Phoenix ICON wide-field infant fundus image. Captured with the Phoenix ICON (100° field of view). 1240x1240px.
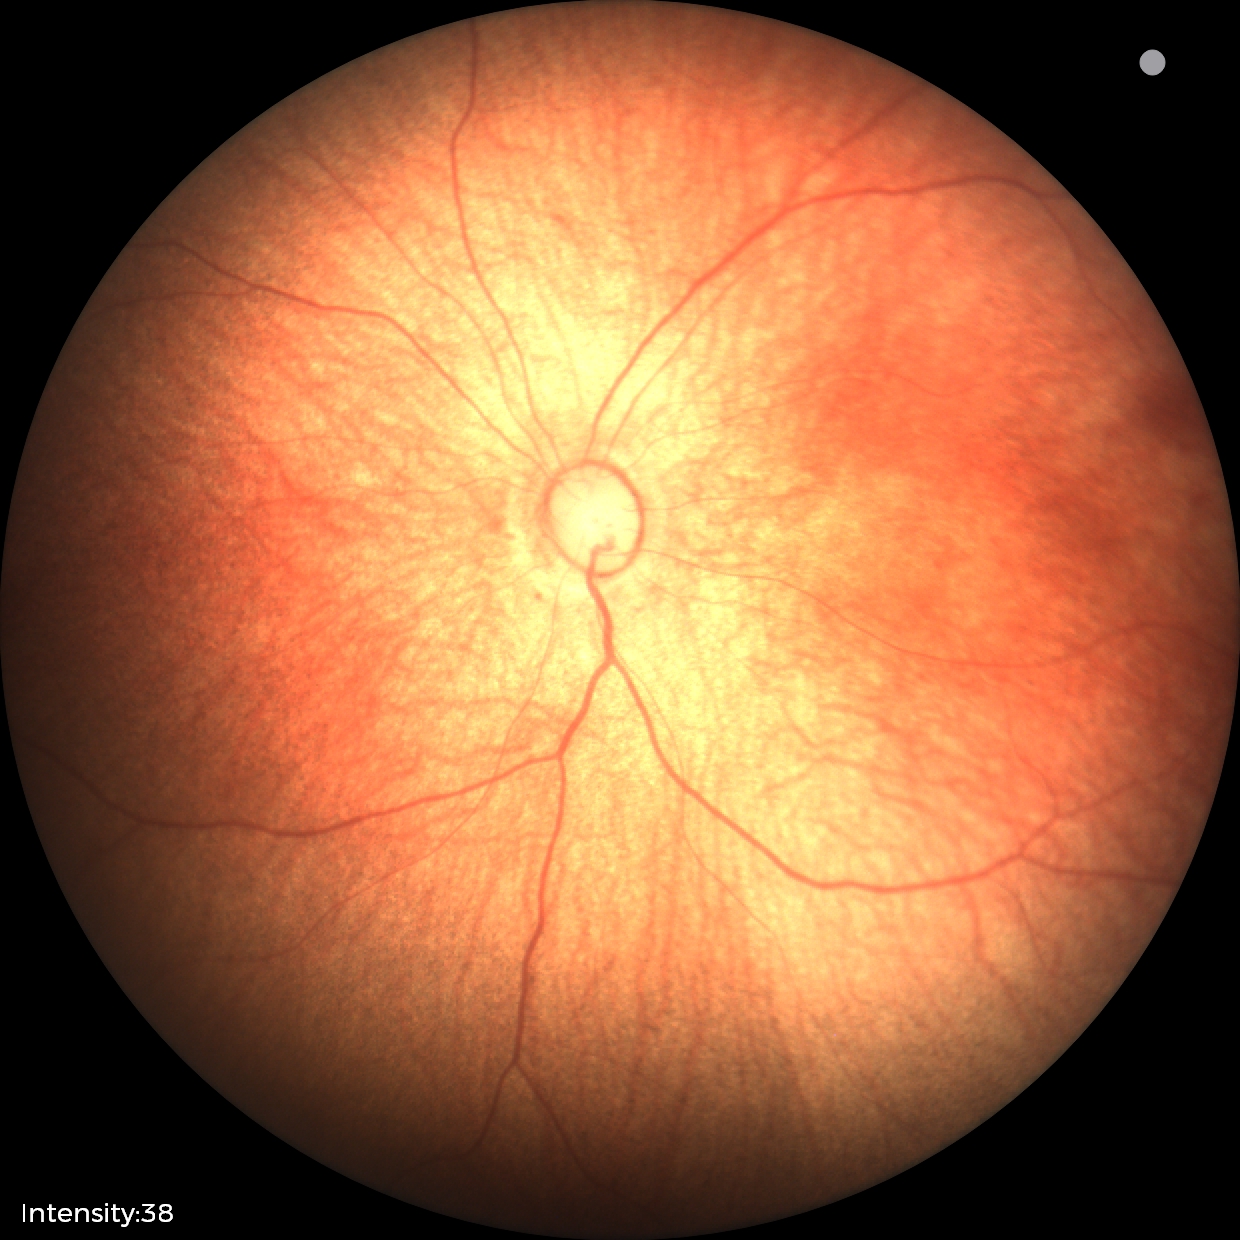 Screening examination with no abnormal retinal findings.